Acquired with a NIDEK AFC-230 — 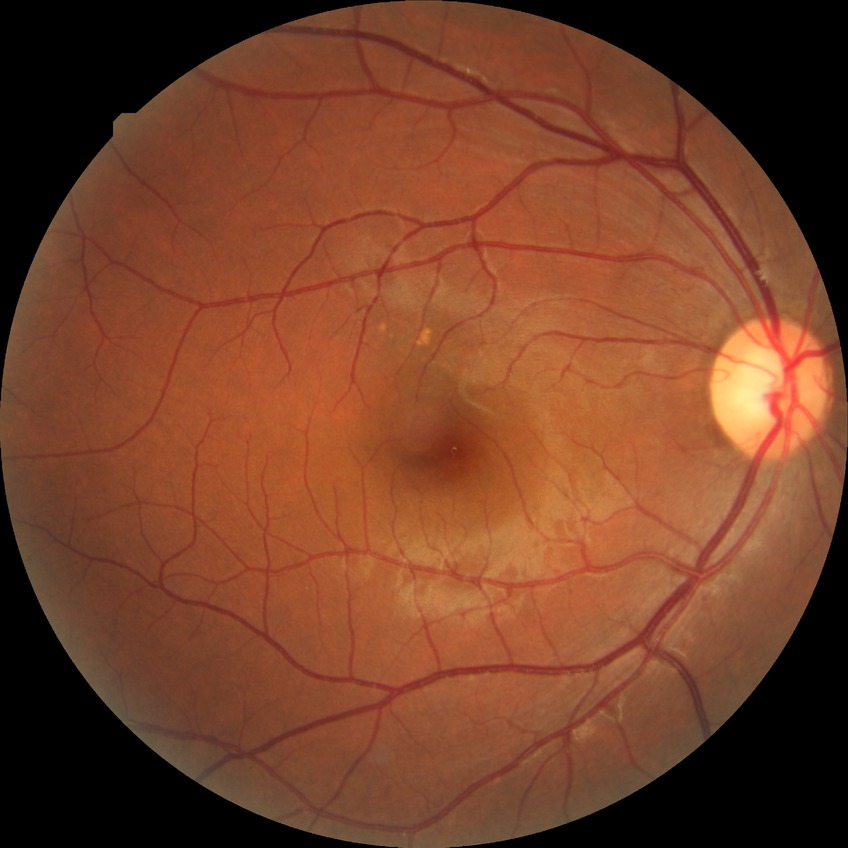 diabetic retinopathy (DR) = NDR (no diabetic retinopathy).